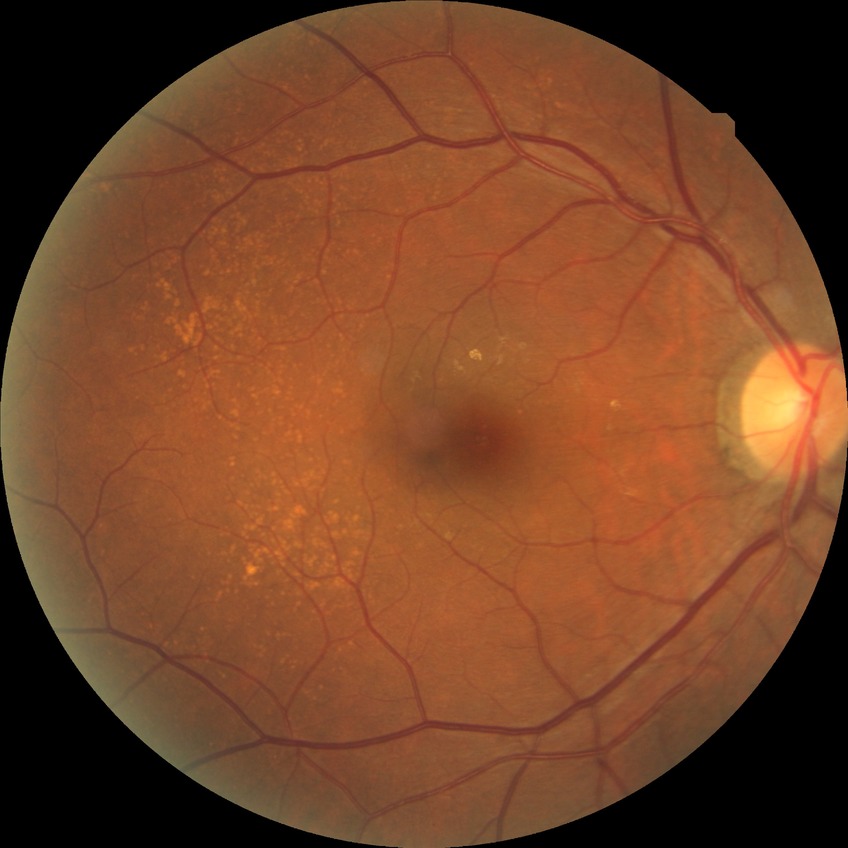
Diabetic retinopathy stage: no diabetic retinopathy.